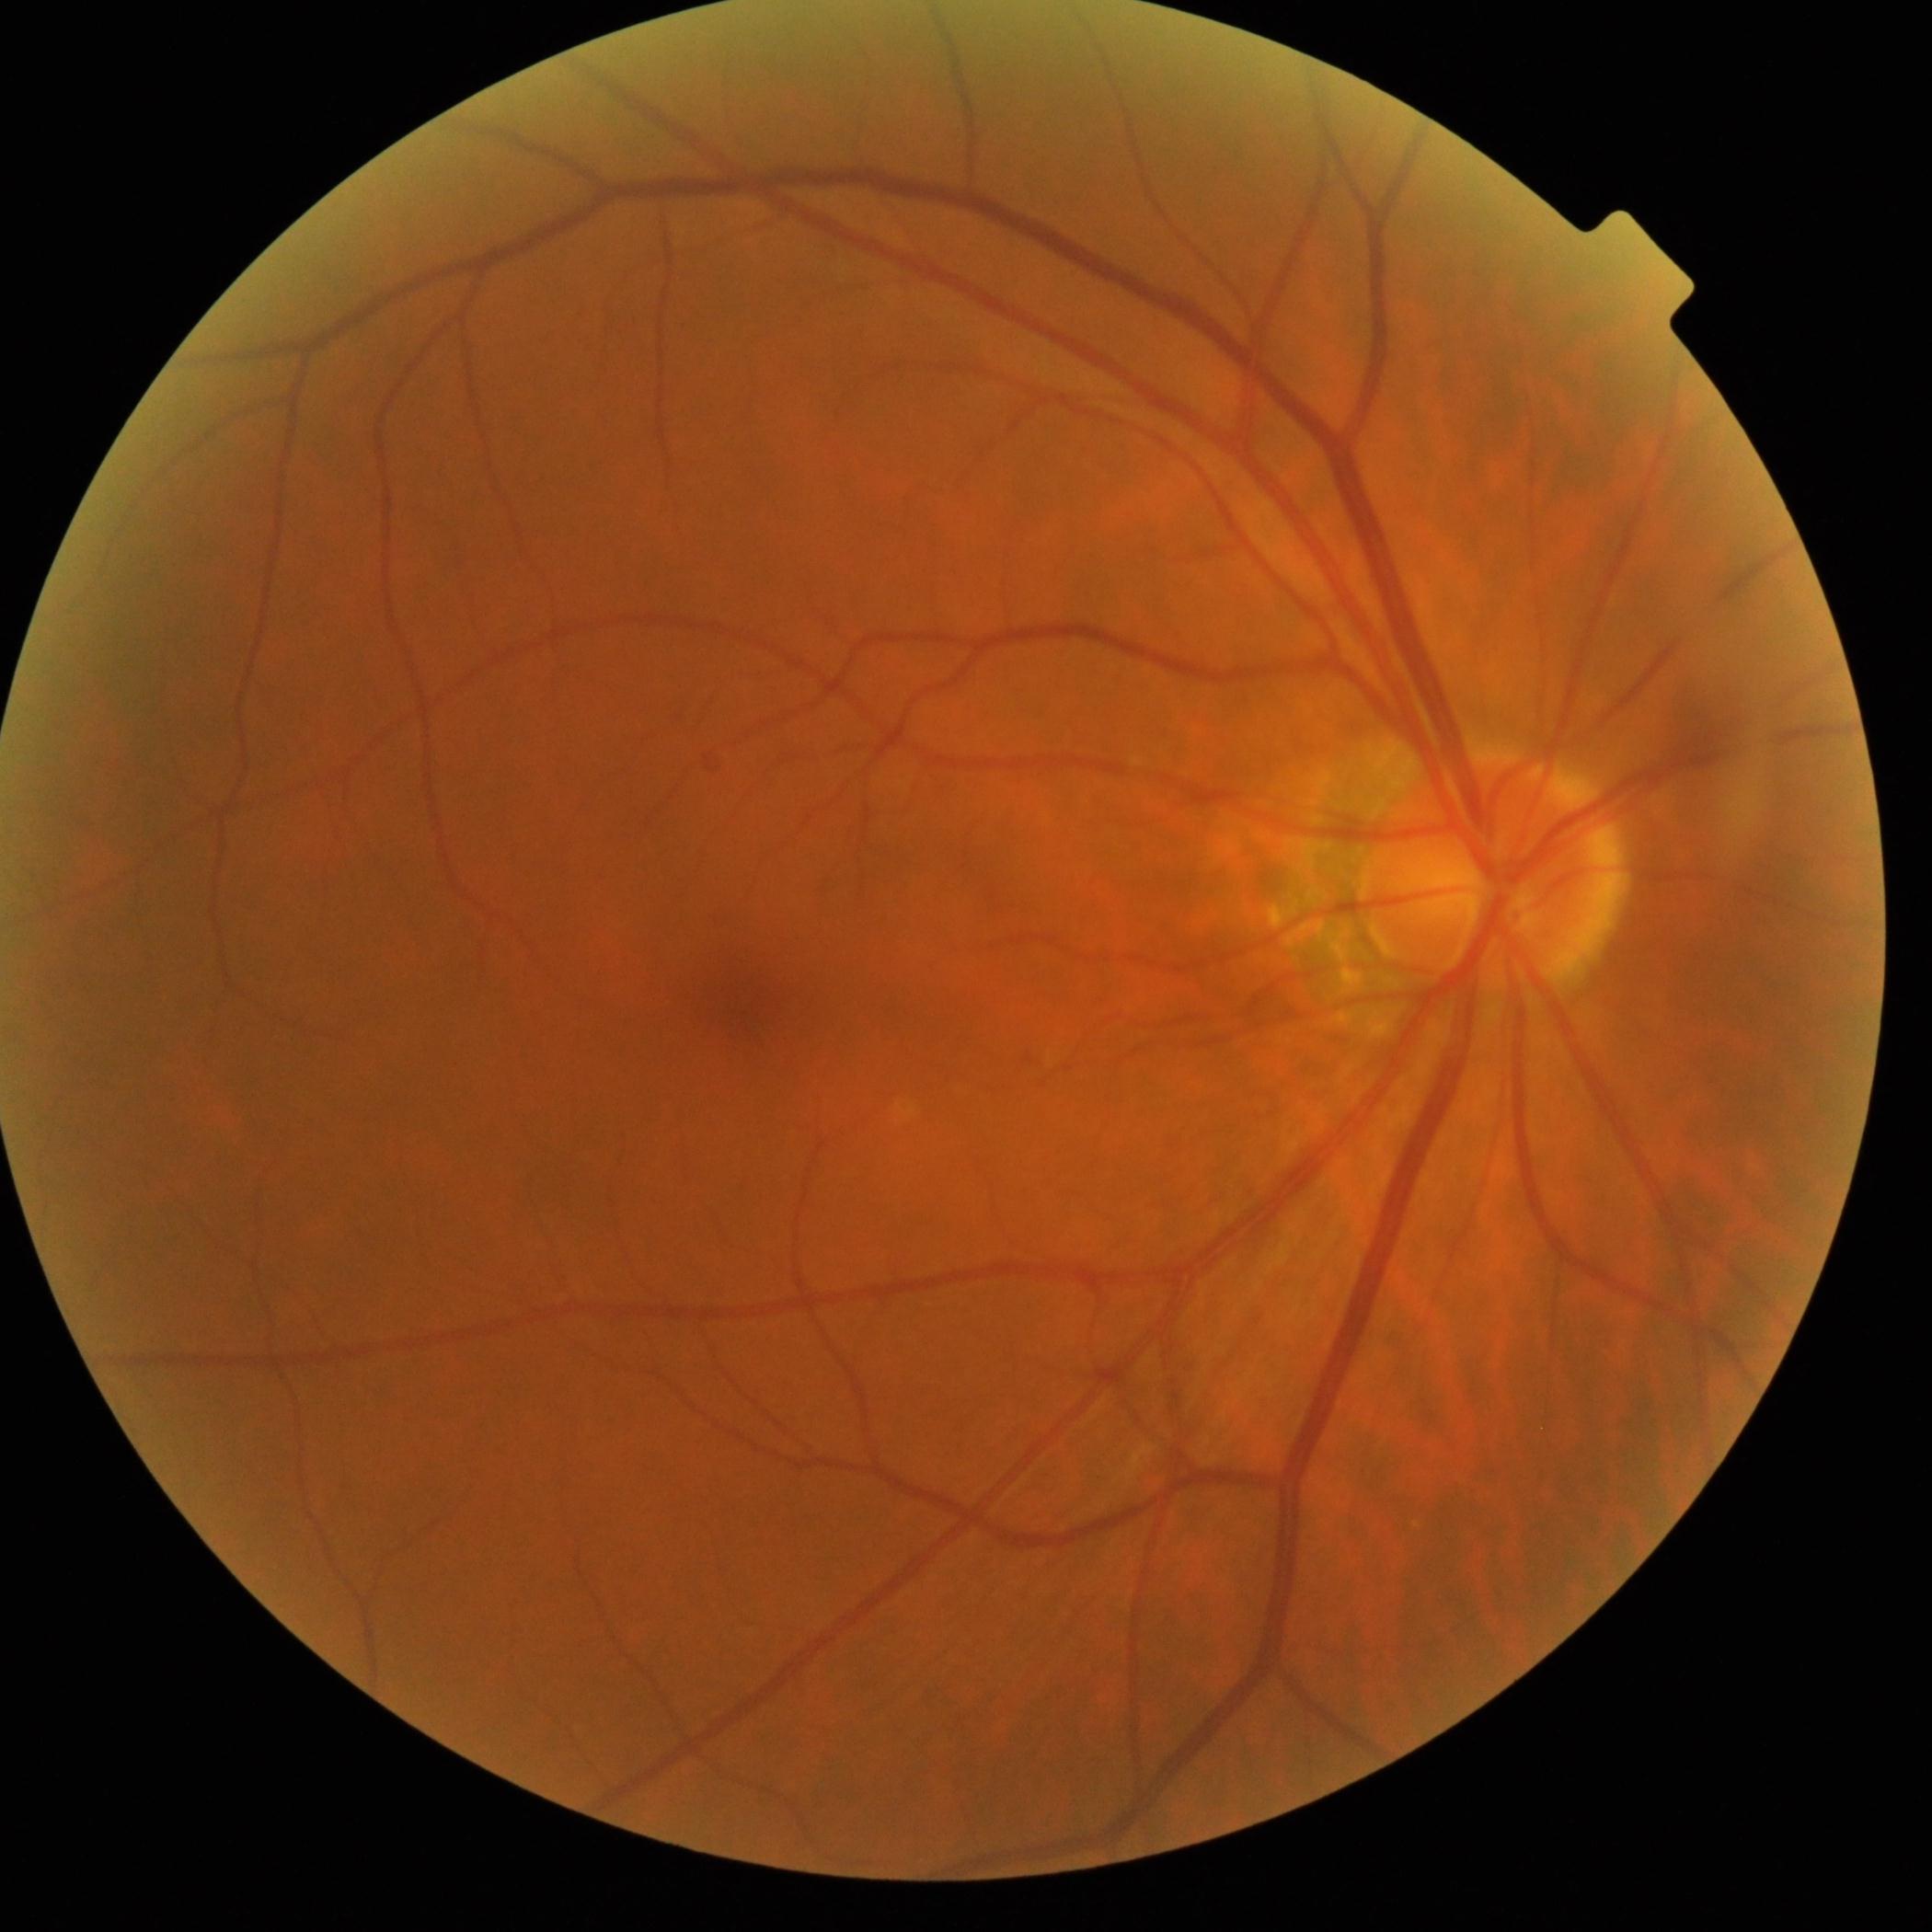

Annotations:
- DR stage — grade 0